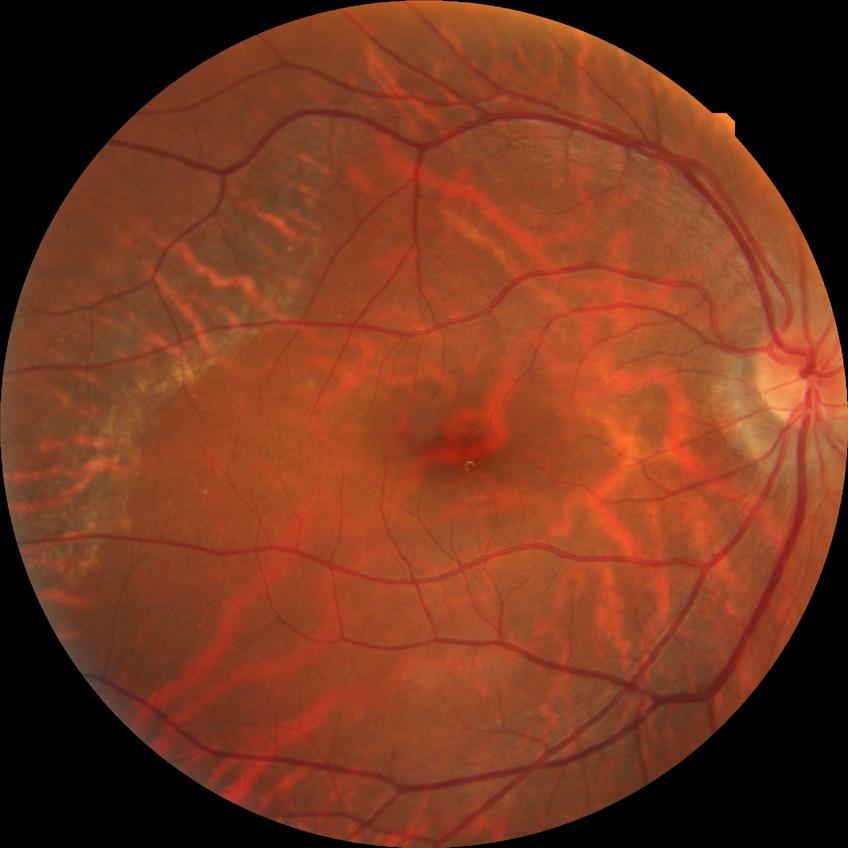

Modified Davis classification is no diabetic retinopathy.